Image size 1440x1080; infant wide-field retinal image:
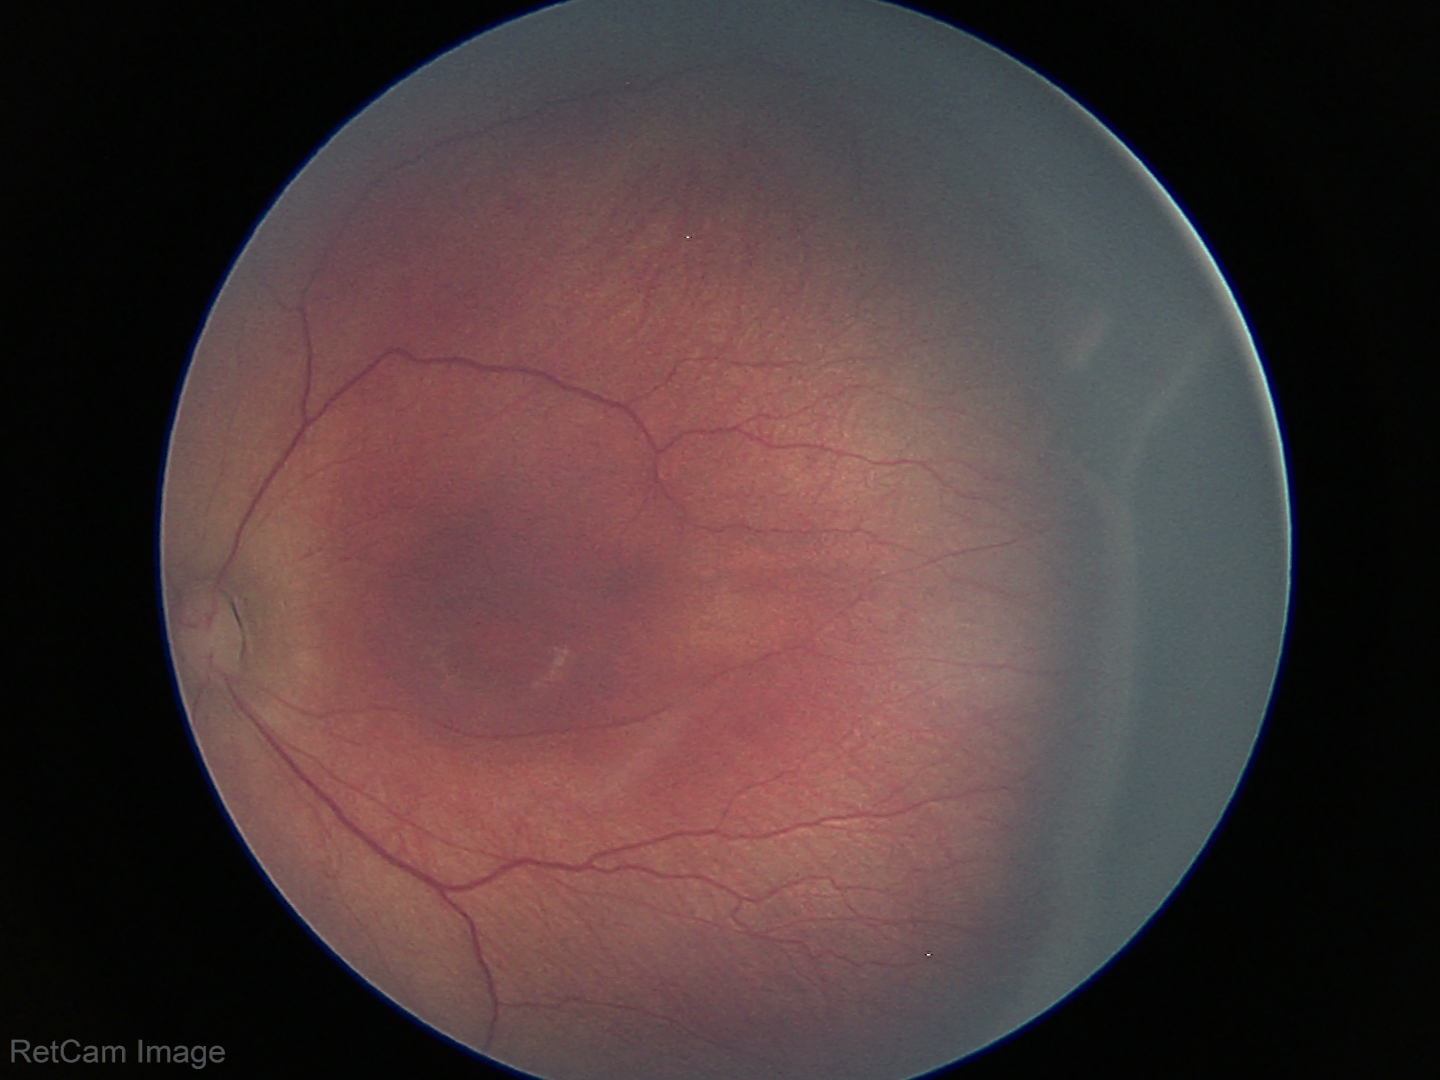
From an examination with diagnosis of retinopathy of prematurity stage 3.